Acquired on the Natus RetCam Envision · 1440 x 1080 pixels · pediatric retinal photograph (wide-field): 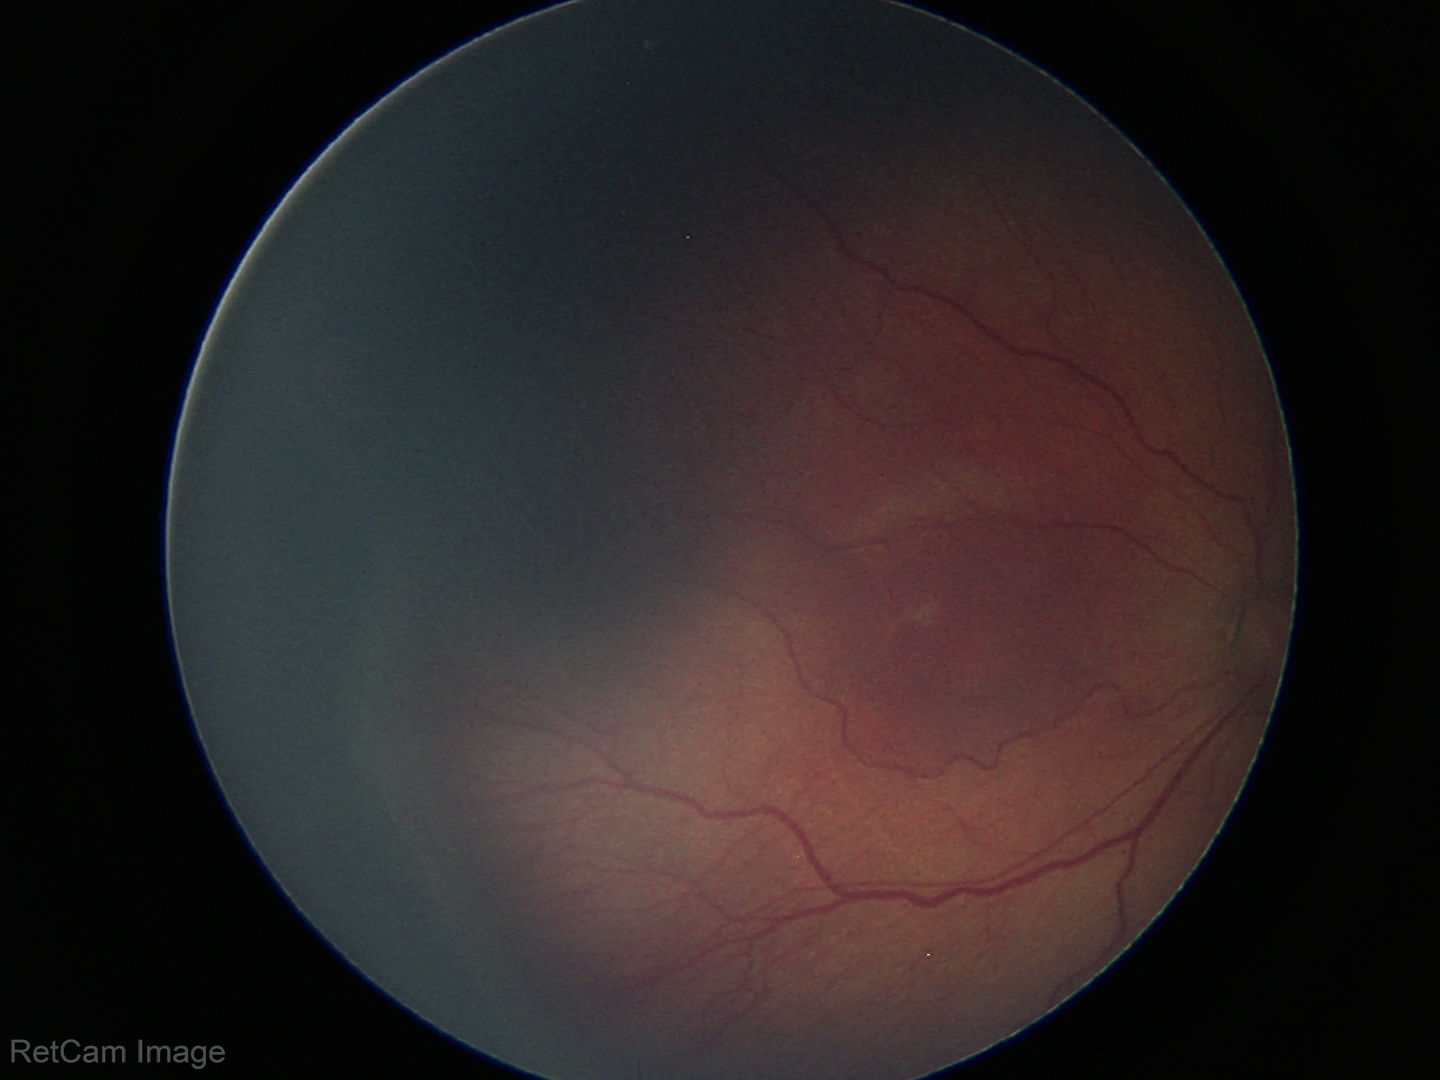
Screening examination consistent with ROP stage 3.